Retinal fundus photograph.
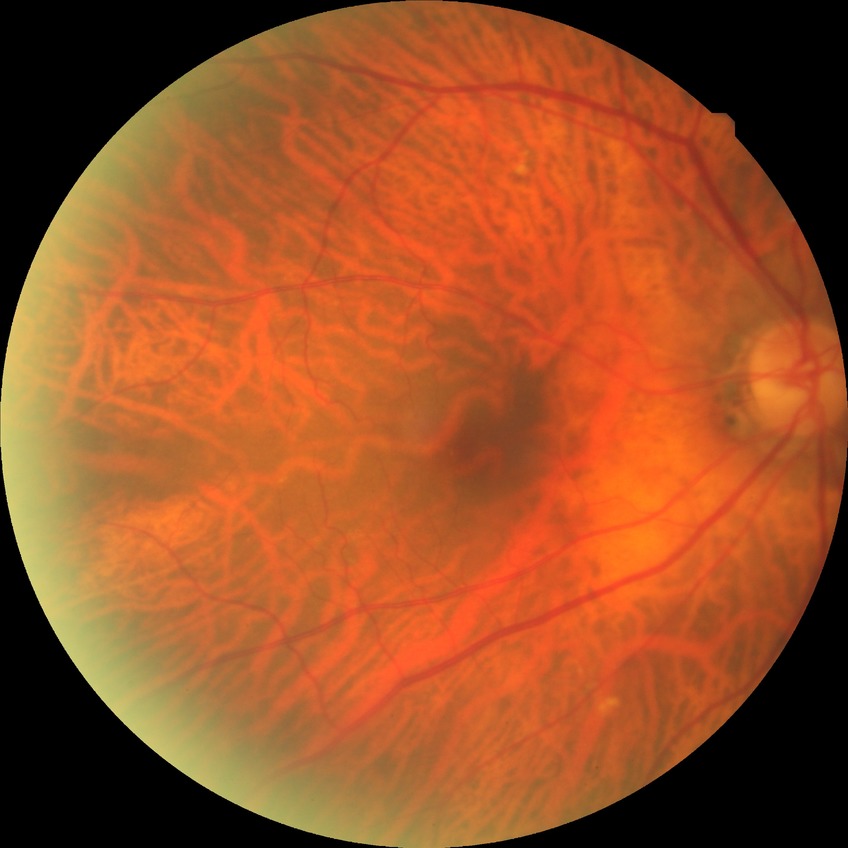
Diabetic retinopathy (DR) is NDR (no diabetic retinopathy).